45° FOV; retinal fundus photograph
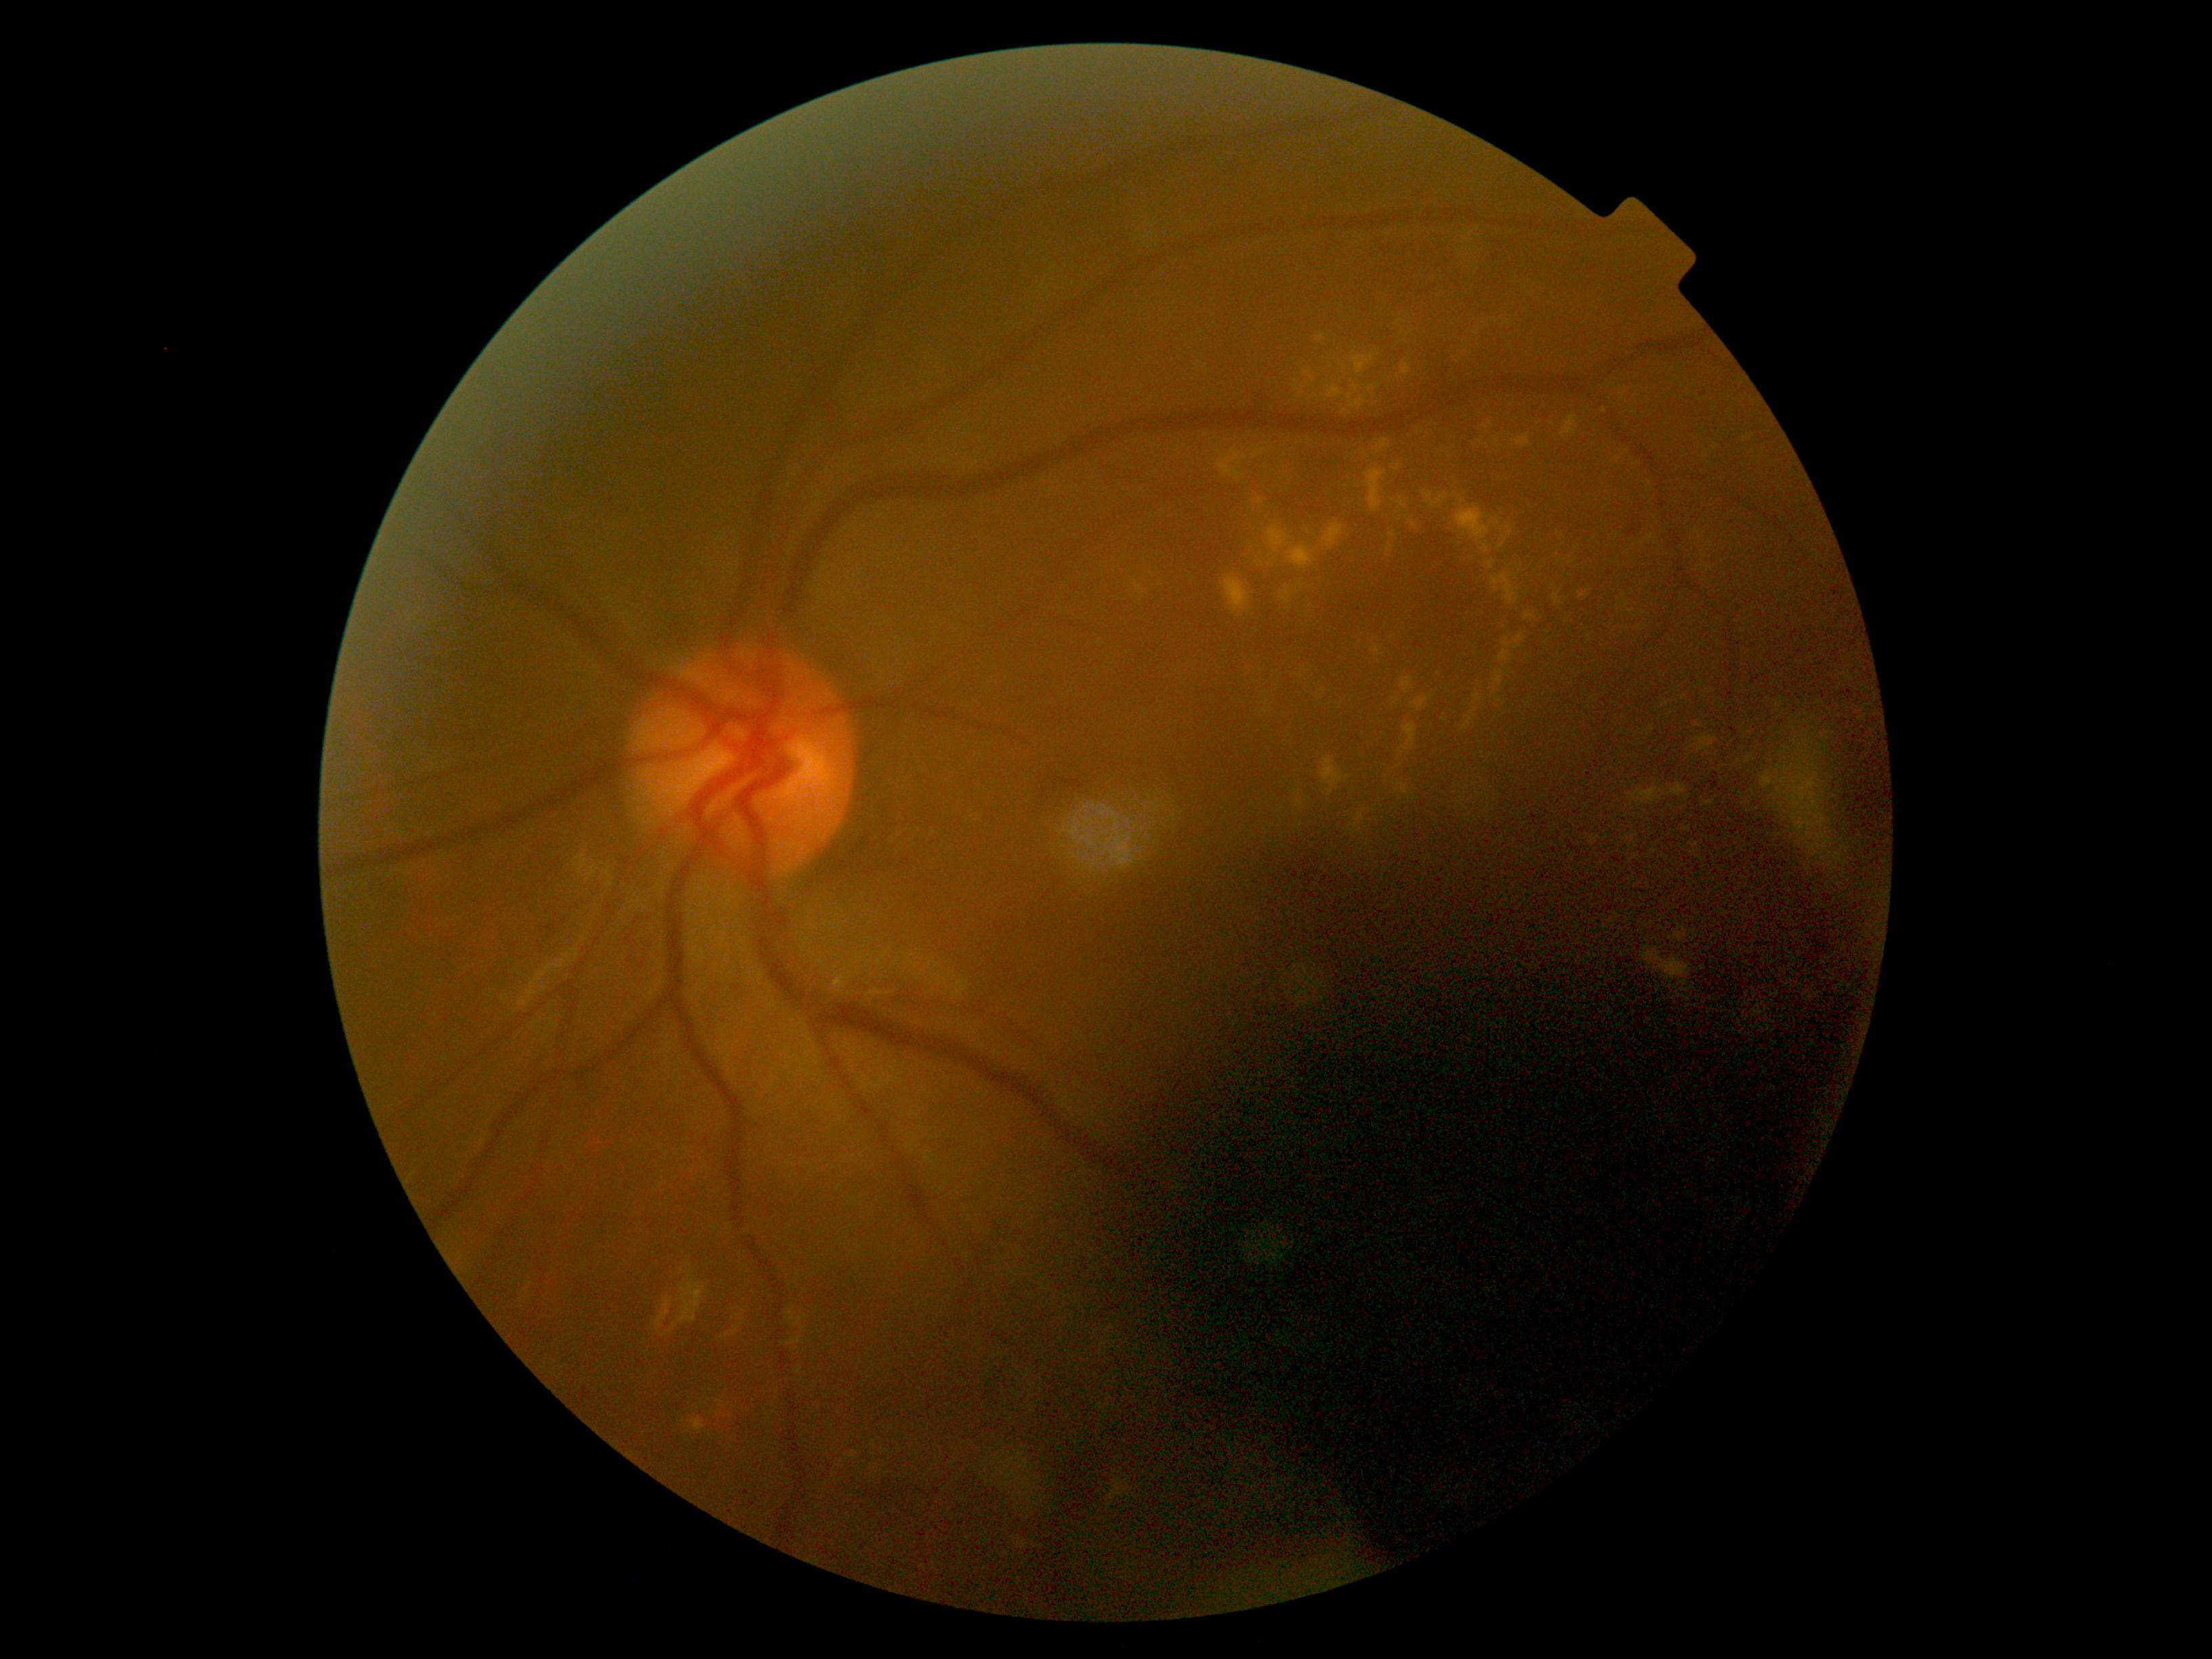

diabetic retinopathy (DR) = grade 2 (moderate NPDR).